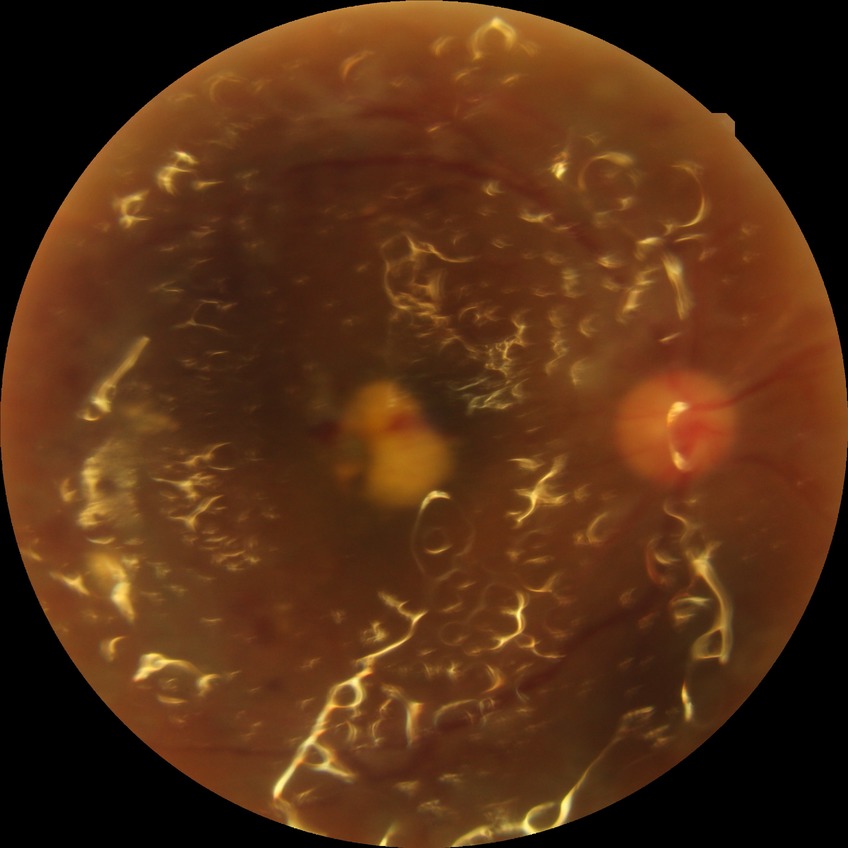

Diabetic retinopathy (DR): proliferative diabetic retinopathy (PDR).